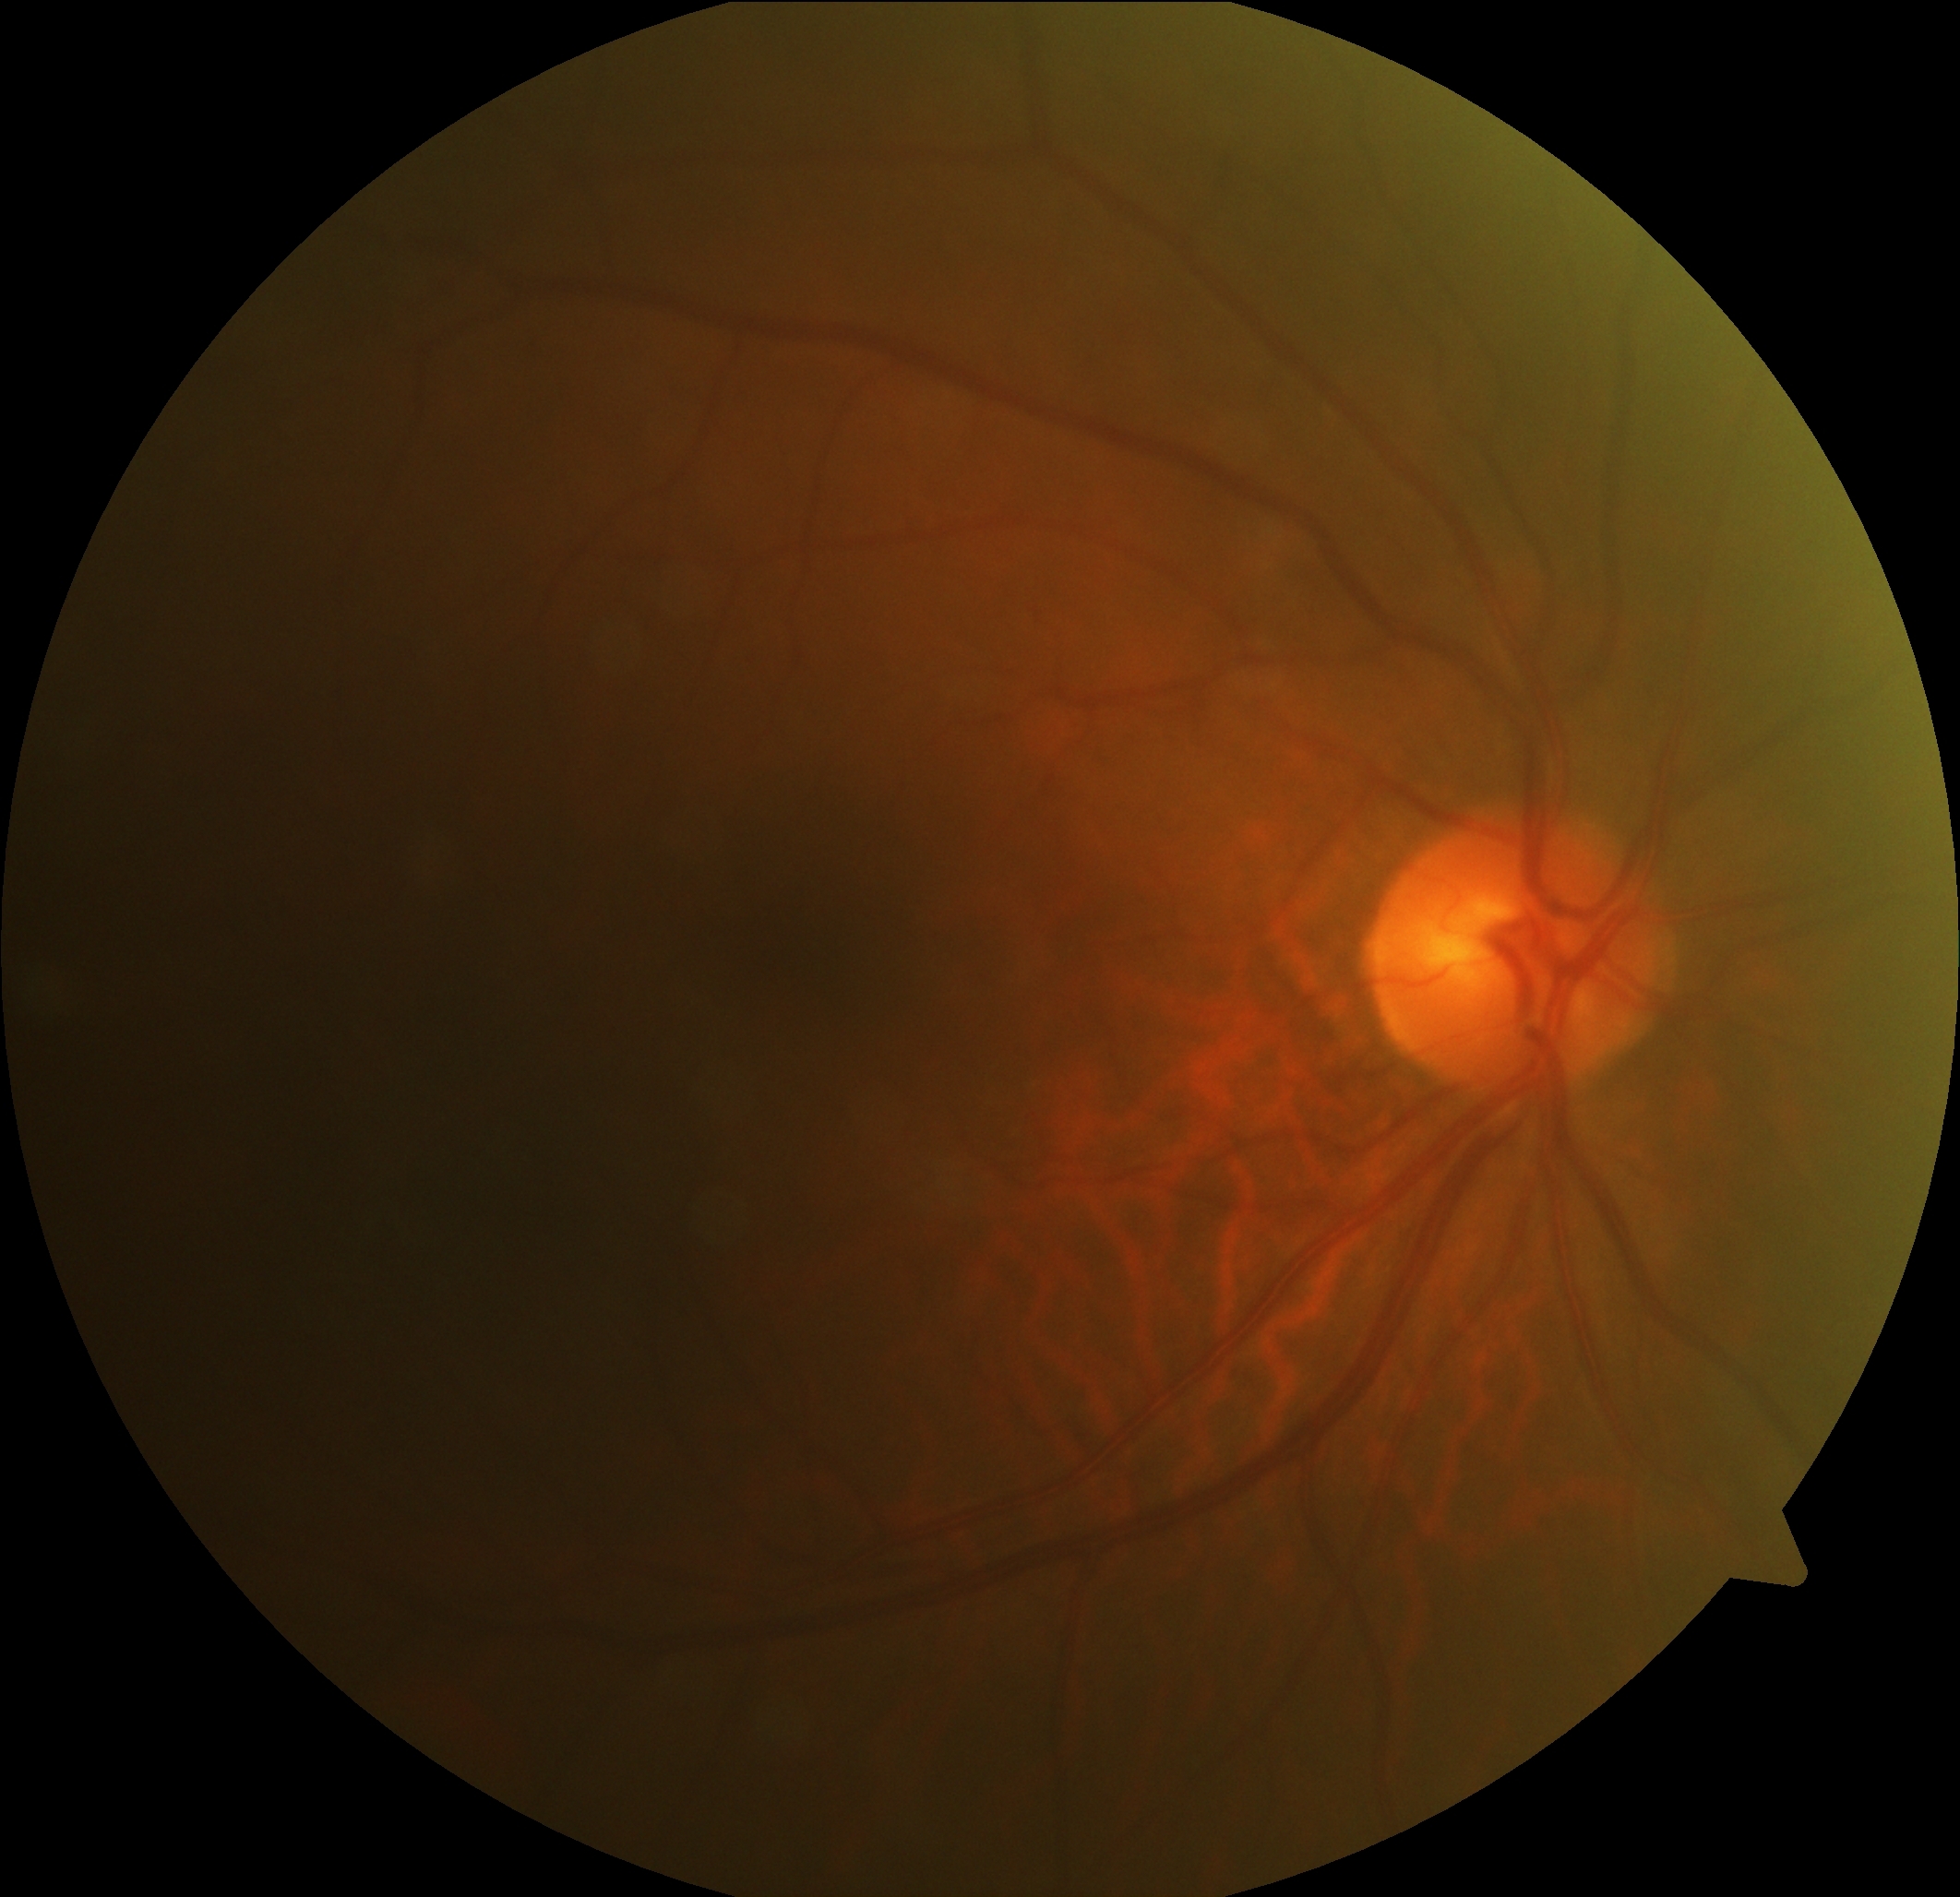

  dr_impression: no DR findings
  dr_grade: no apparent retinopathy (grade 0)